Color fundus image — 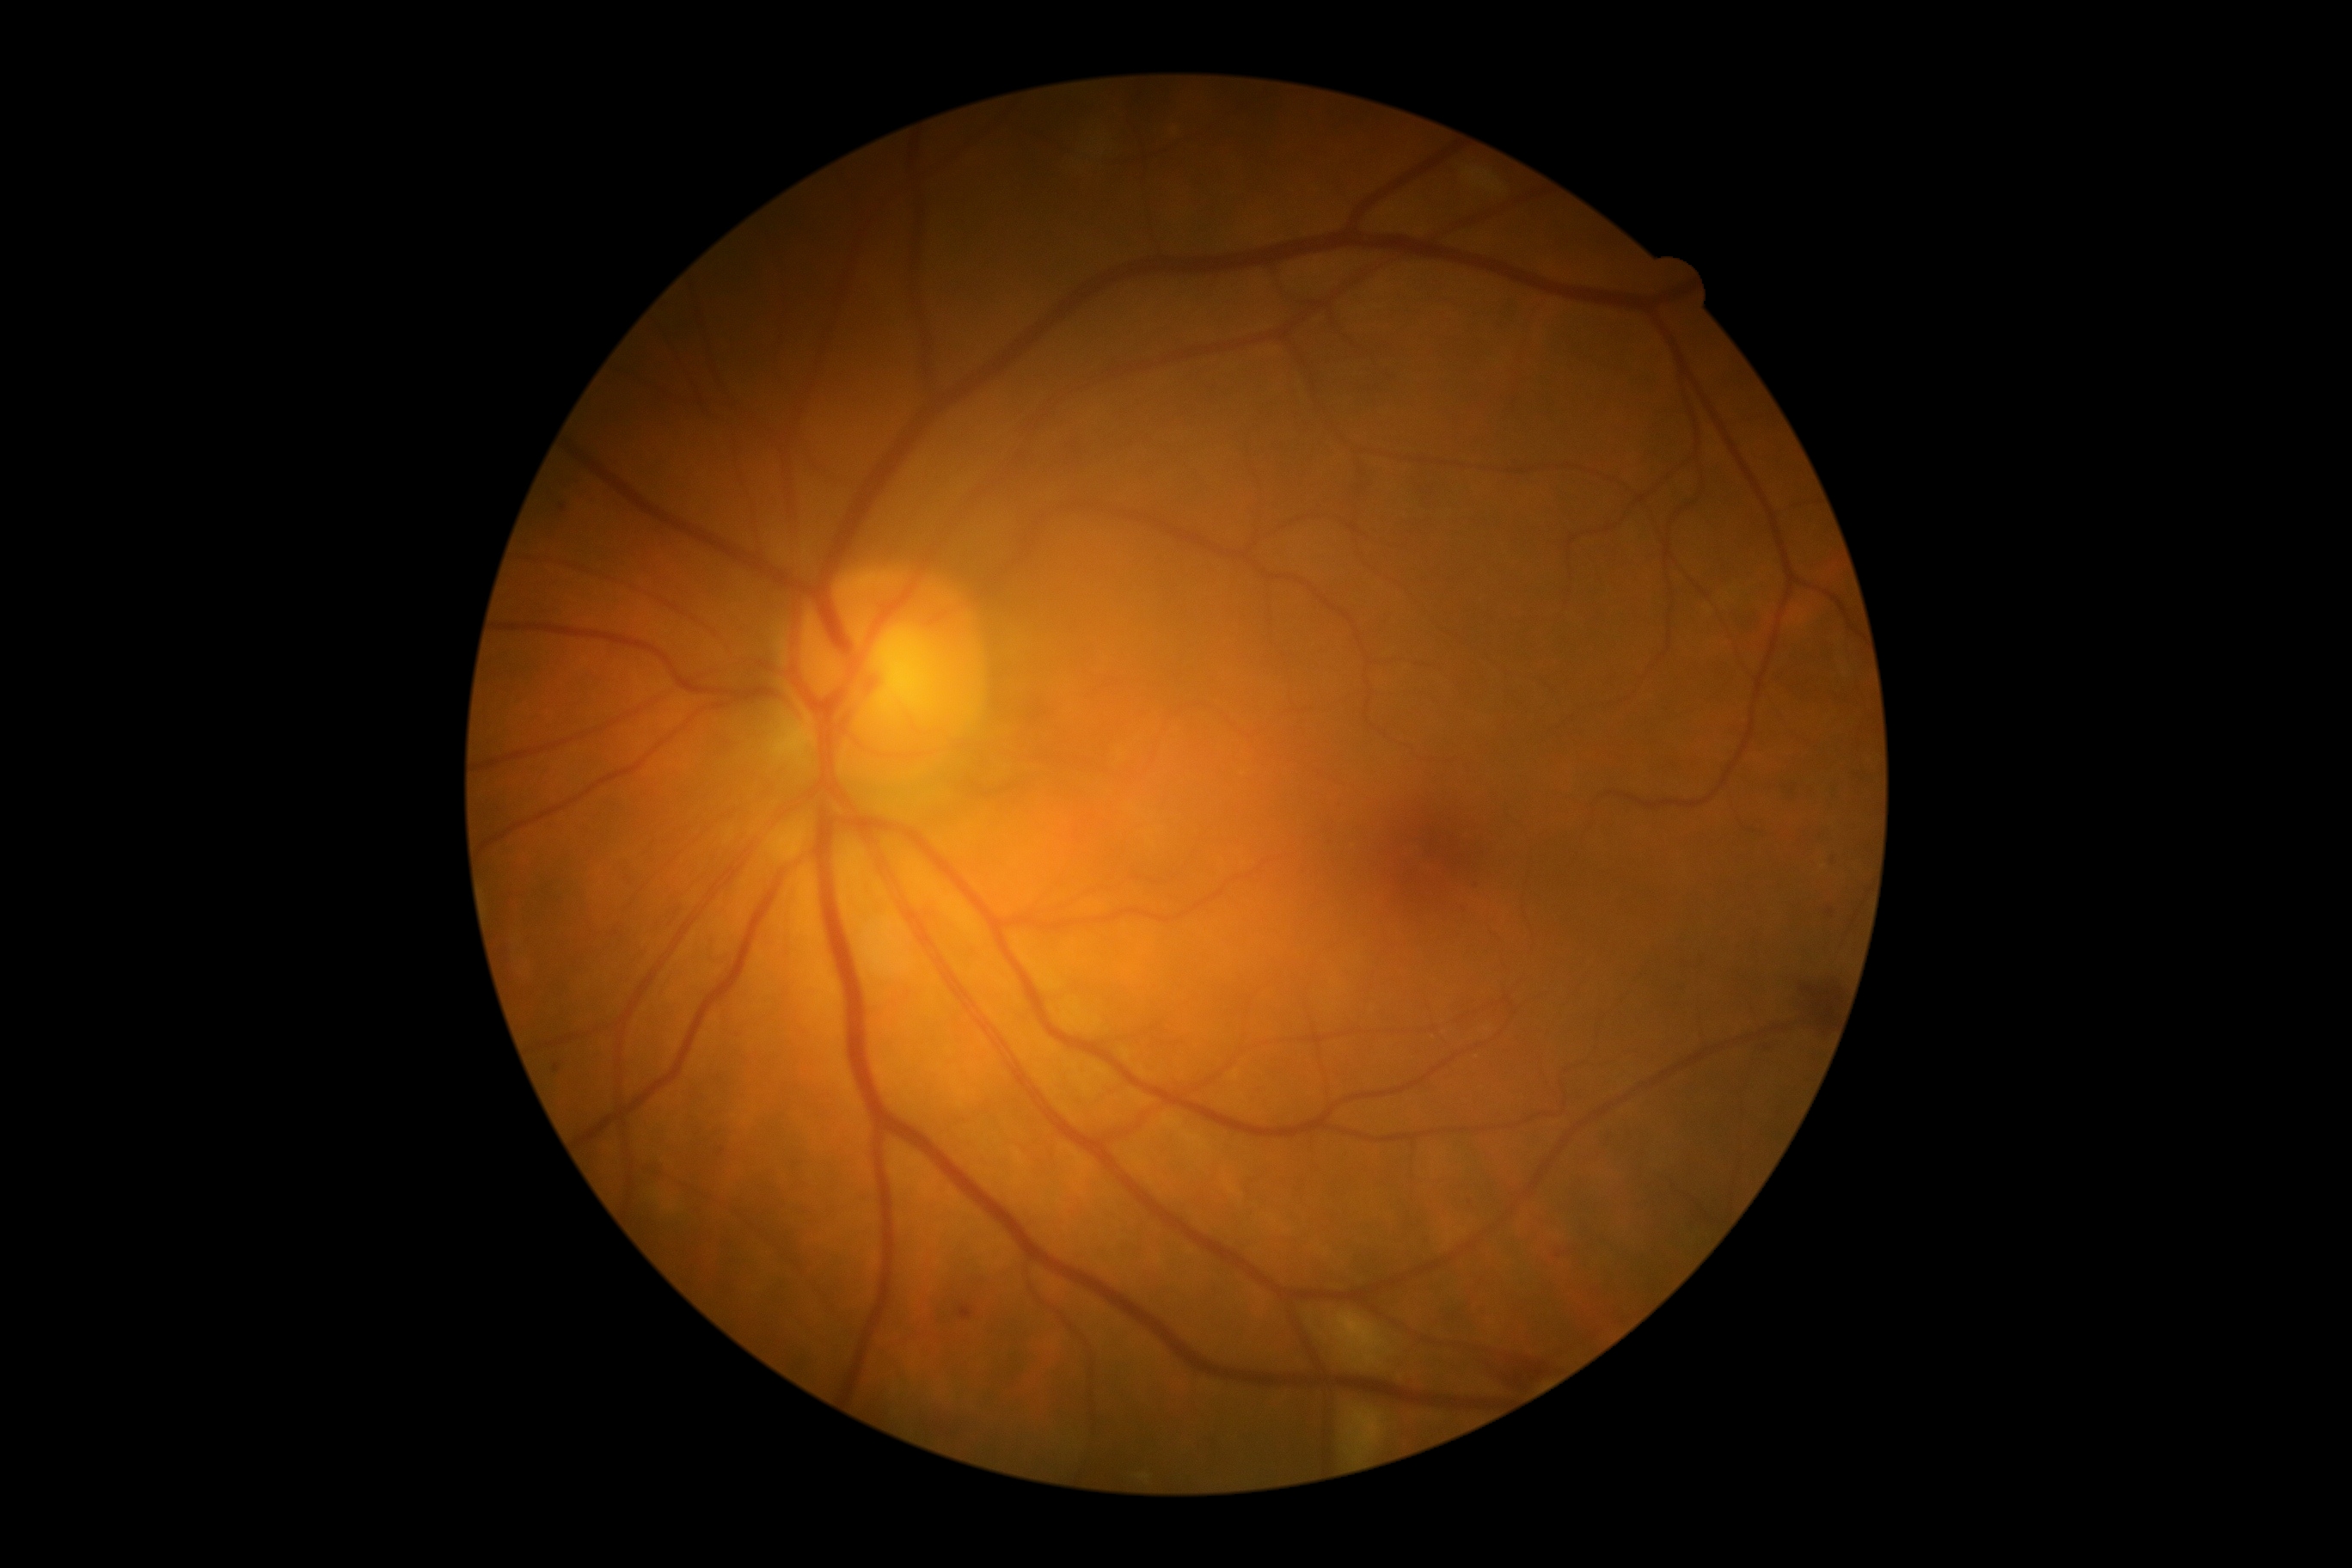
Retinopathy grade is 2 (moderate NPDR).